FOV: 45 degrees · 2212x1659 — 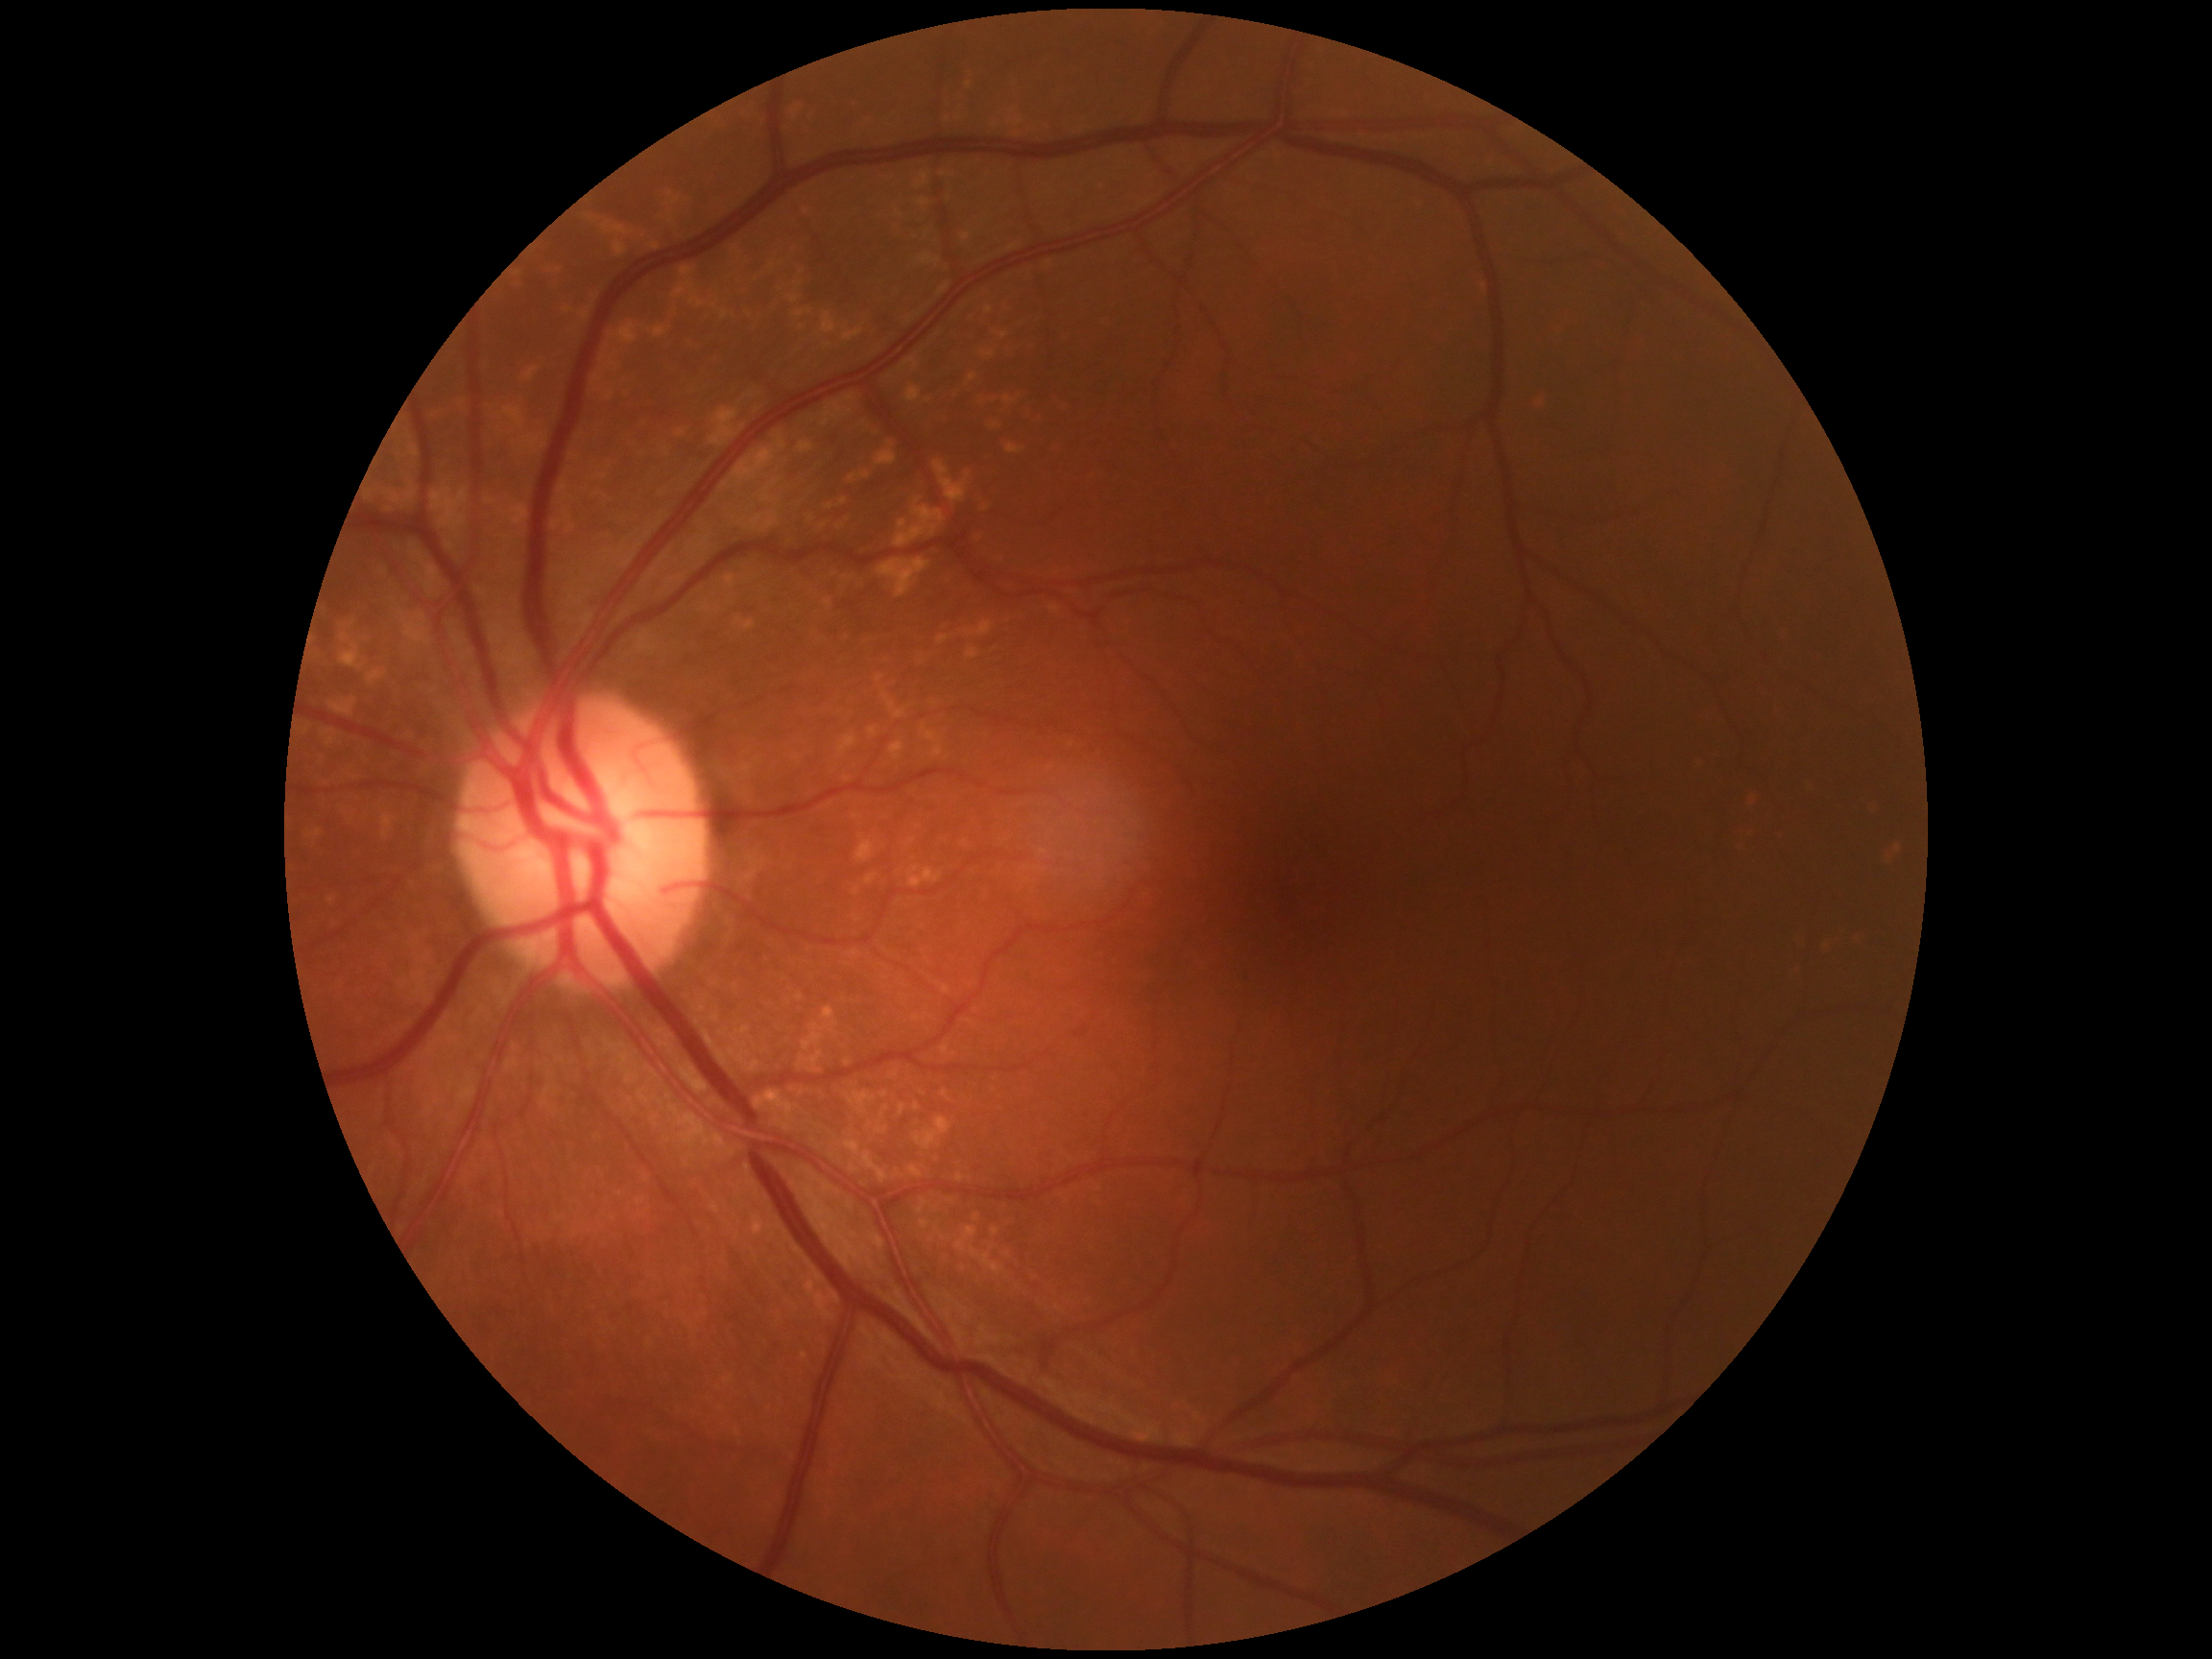

Diabetic retinopathy is 0/4.